45° field of view.
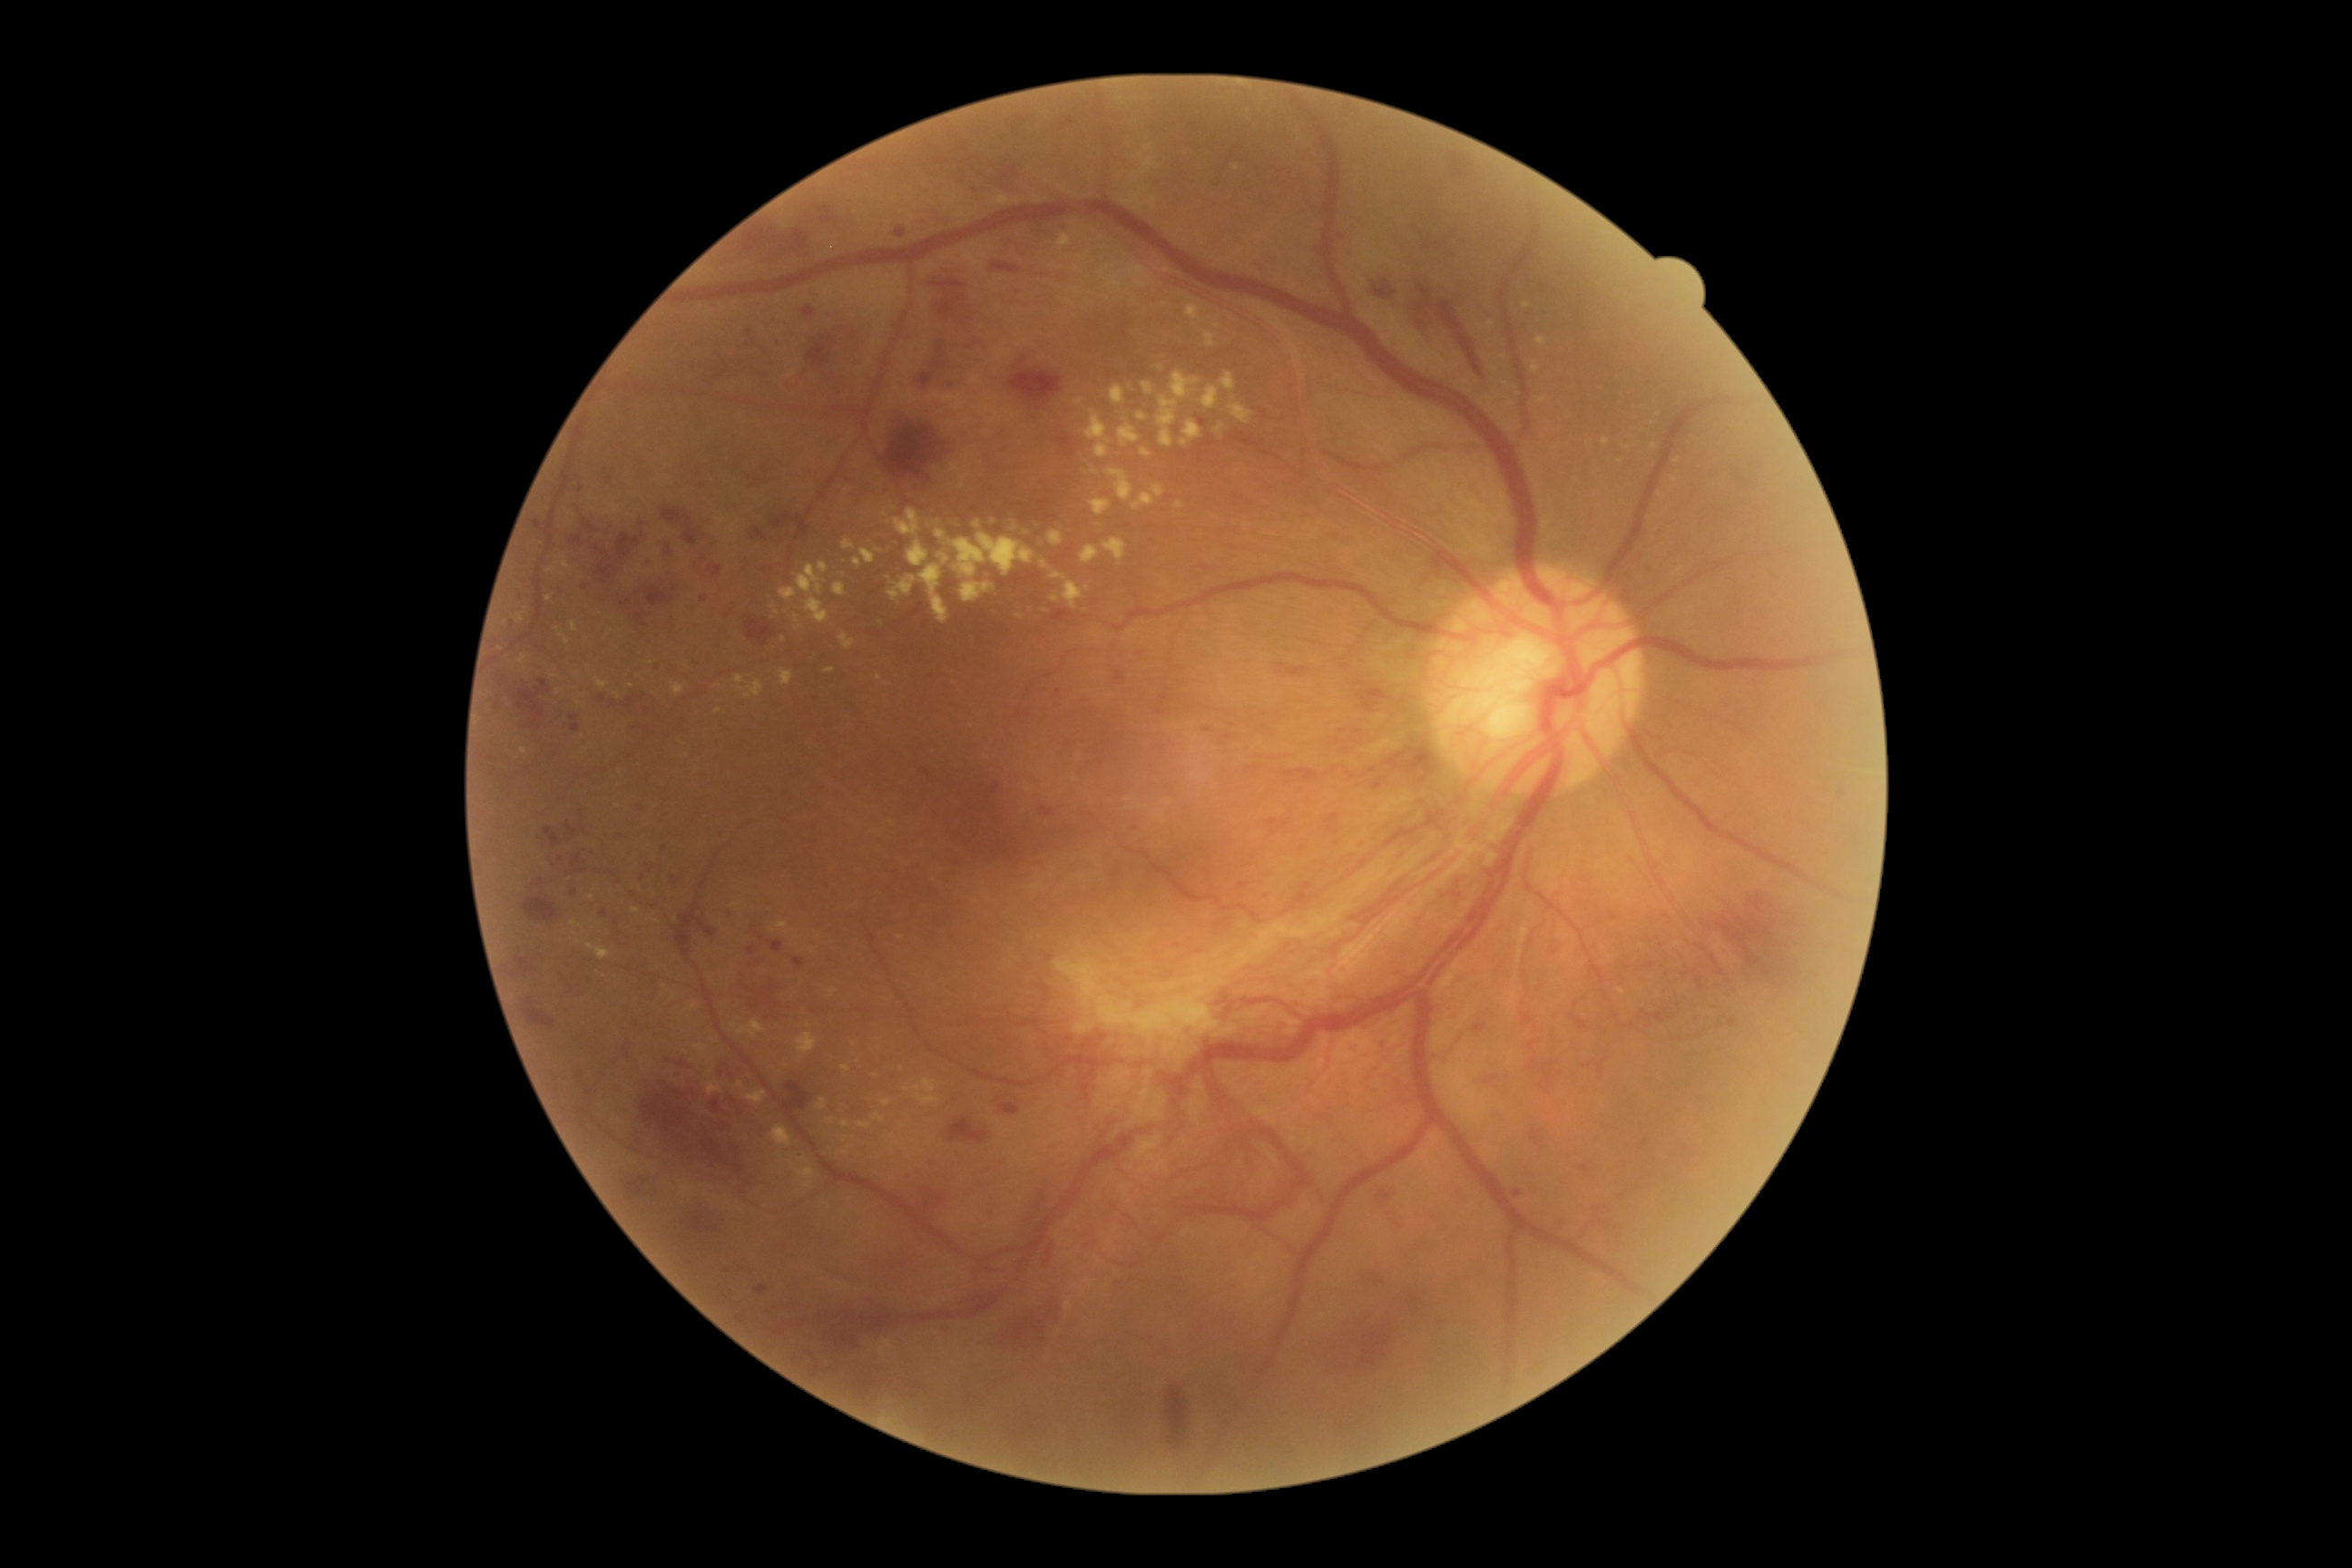

<lesions partial="true">
  <dr_grade>4</dr_grade>
  <ex partial="true">1186 304 1200 320 | 611 504 622 513 | 858 1122 870 1130 | 1110 386 1126 406 | 631 908 642 914 | 651 917 660 925 | 816 1099 828 1112 | 825 669 834 674 | 1086 411 1108 442 | 770 1126 792 1146 | 1206 333 1215 348 | 919 565 948 625</ex>
  <ex_small_centers>point(1167, 270) | point(1108, 442) | point(620, 773) | point(1029, 790) | point(734, 1026) | point(1020, 617)</ex_small_centers>
  <ma partial="true">803 308 816 317 | 729 908 732 917 | 636 799 643 807 | 794 957 805 968 | 534 879 544 887 | 1200 418 1208 427 | 596 694 607 705</ma>
  <ma_small_centers>point(1266, 895) | point(658, 667) | point(616, 922) | point(604, 913) | point(1377, 786) | point(1358, 844) | point(1732, 1024) | point(585, 589)</ma_small_centers>
  <he partial="true">928 264 972 329 | 772 520 783 529 | 994 172 1021 197 | 1010 371 1061 404 | 745 616 776 645 | 1522 1014 1534 1026 | 818 1266 865 1289 | 966 1293 994 1304 | 1598 1064 1603 1077 | 663 1059 694 1070 | 1718 908 1801 977 | 663 536 672 560 | 1115 672 1126 683 | 750 529 769 540 | 571 538 582 545 | 1017 119 1026 124 | 1542 1068 1553 1092 | 919 1191 943 1211</he>
  <he_small_centers>point(1363, 845)</he_small_centers>
</lesions>